Ultra-widefield (UWF) fundus image · image size 1924x1556
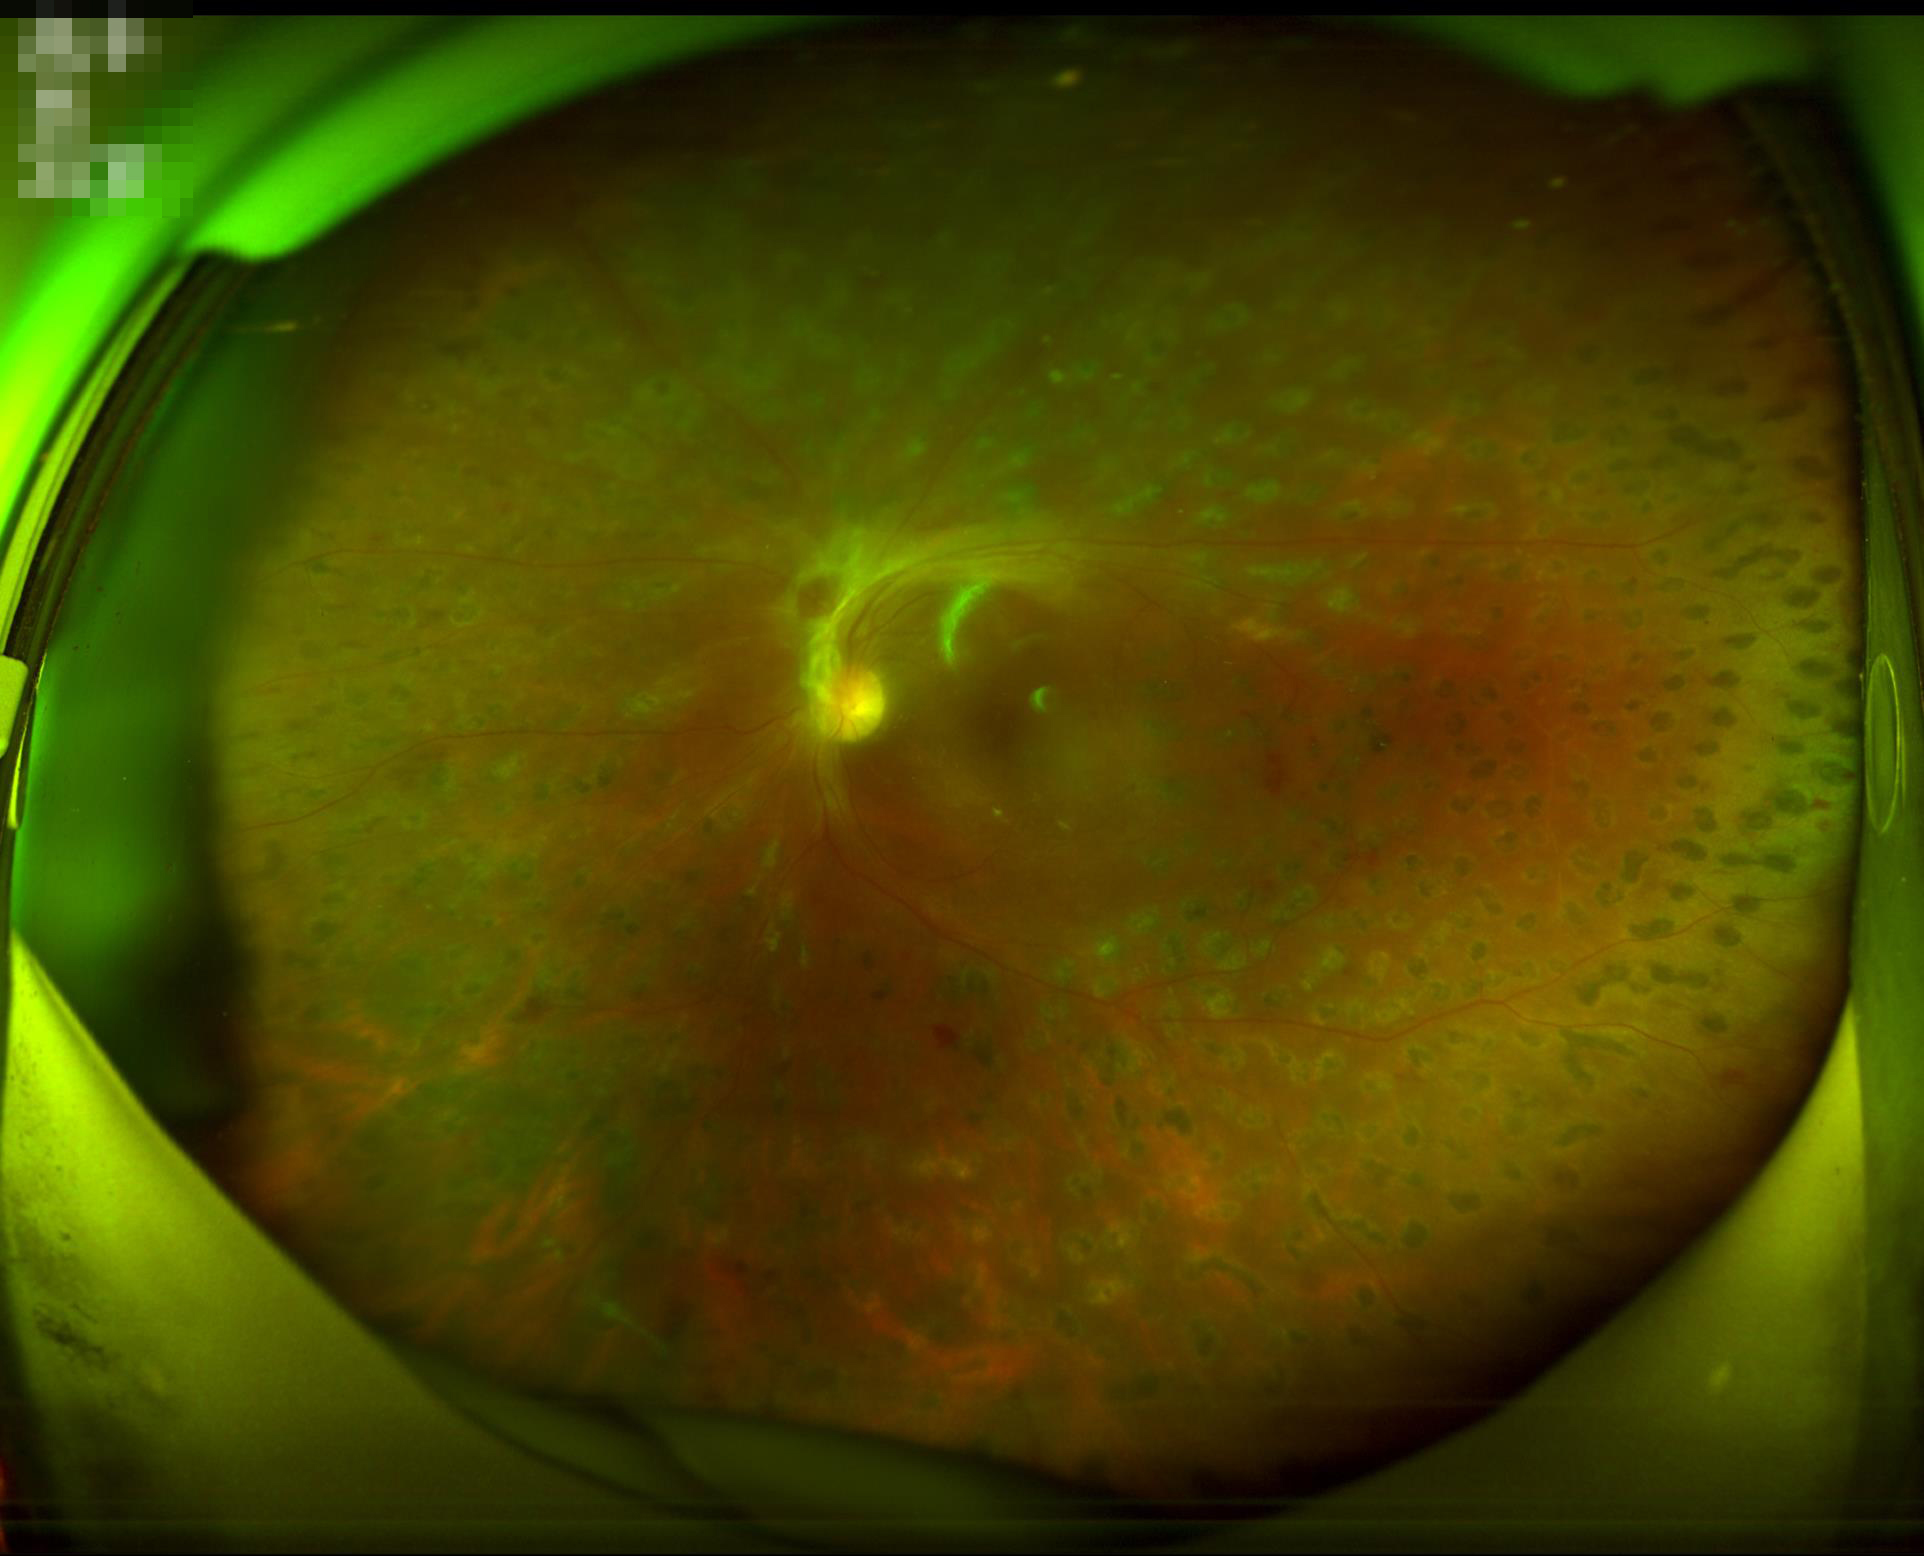

overall_quality: poor
contrast: low
clarity: blurry